2048x1536px.
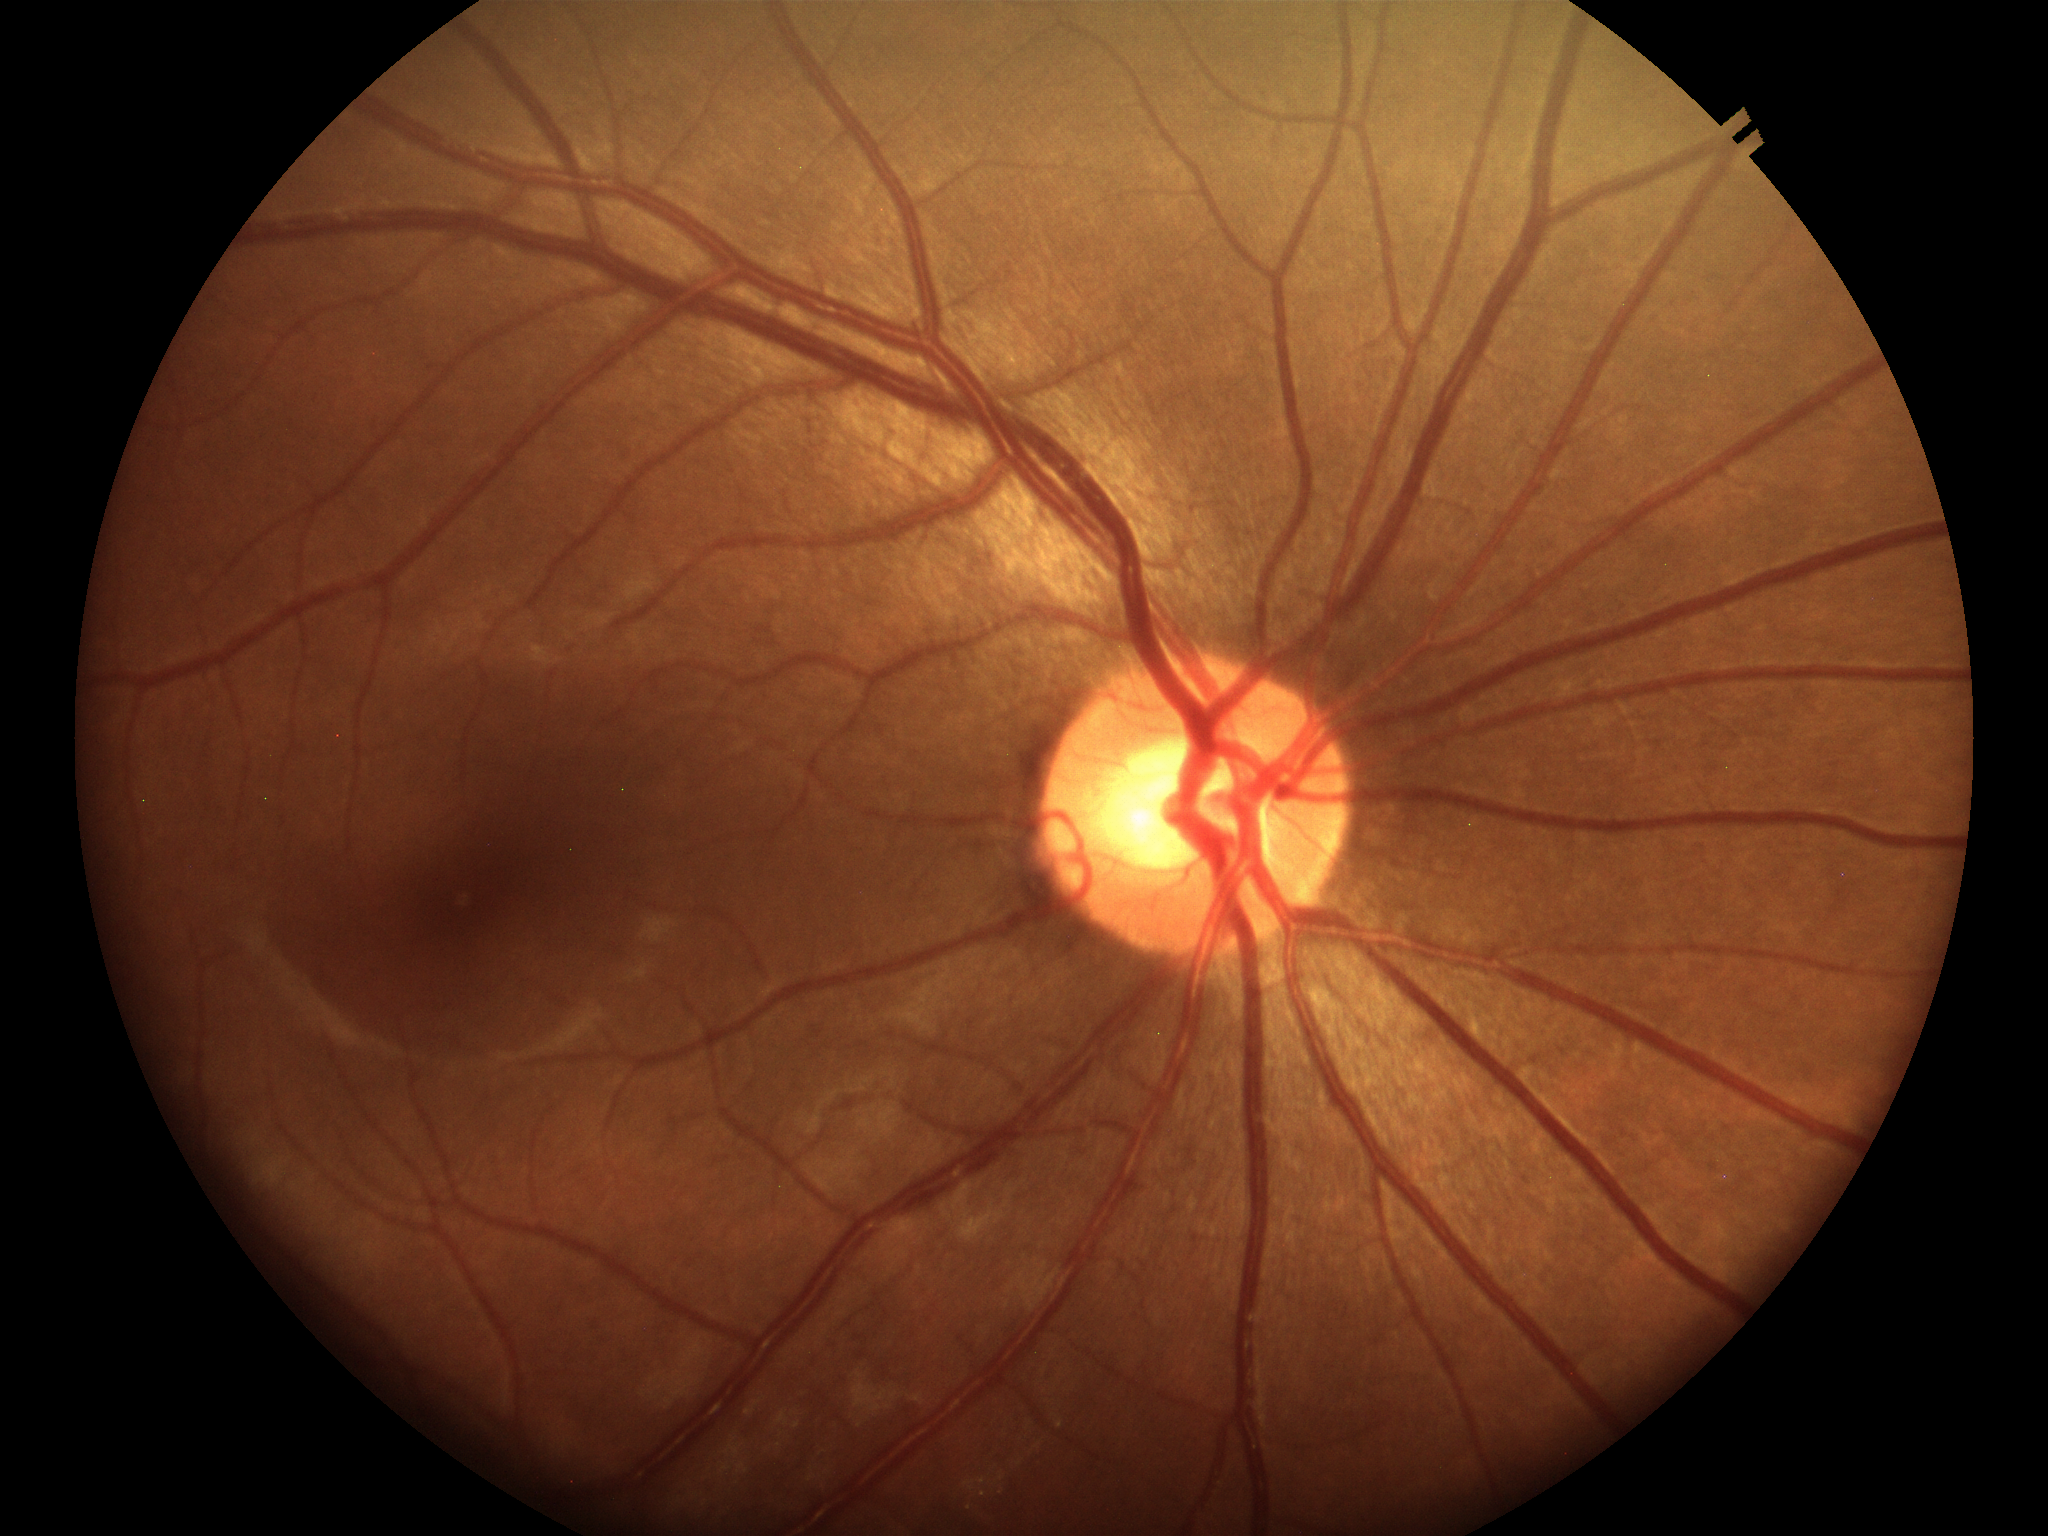
Glaucoma decision: no suspicious findings.
Horizontal C/D ratio (HCDR) is 0.55.
Vertical cup-to-disc ratio (VCDR) of 0.46.